45° field of view
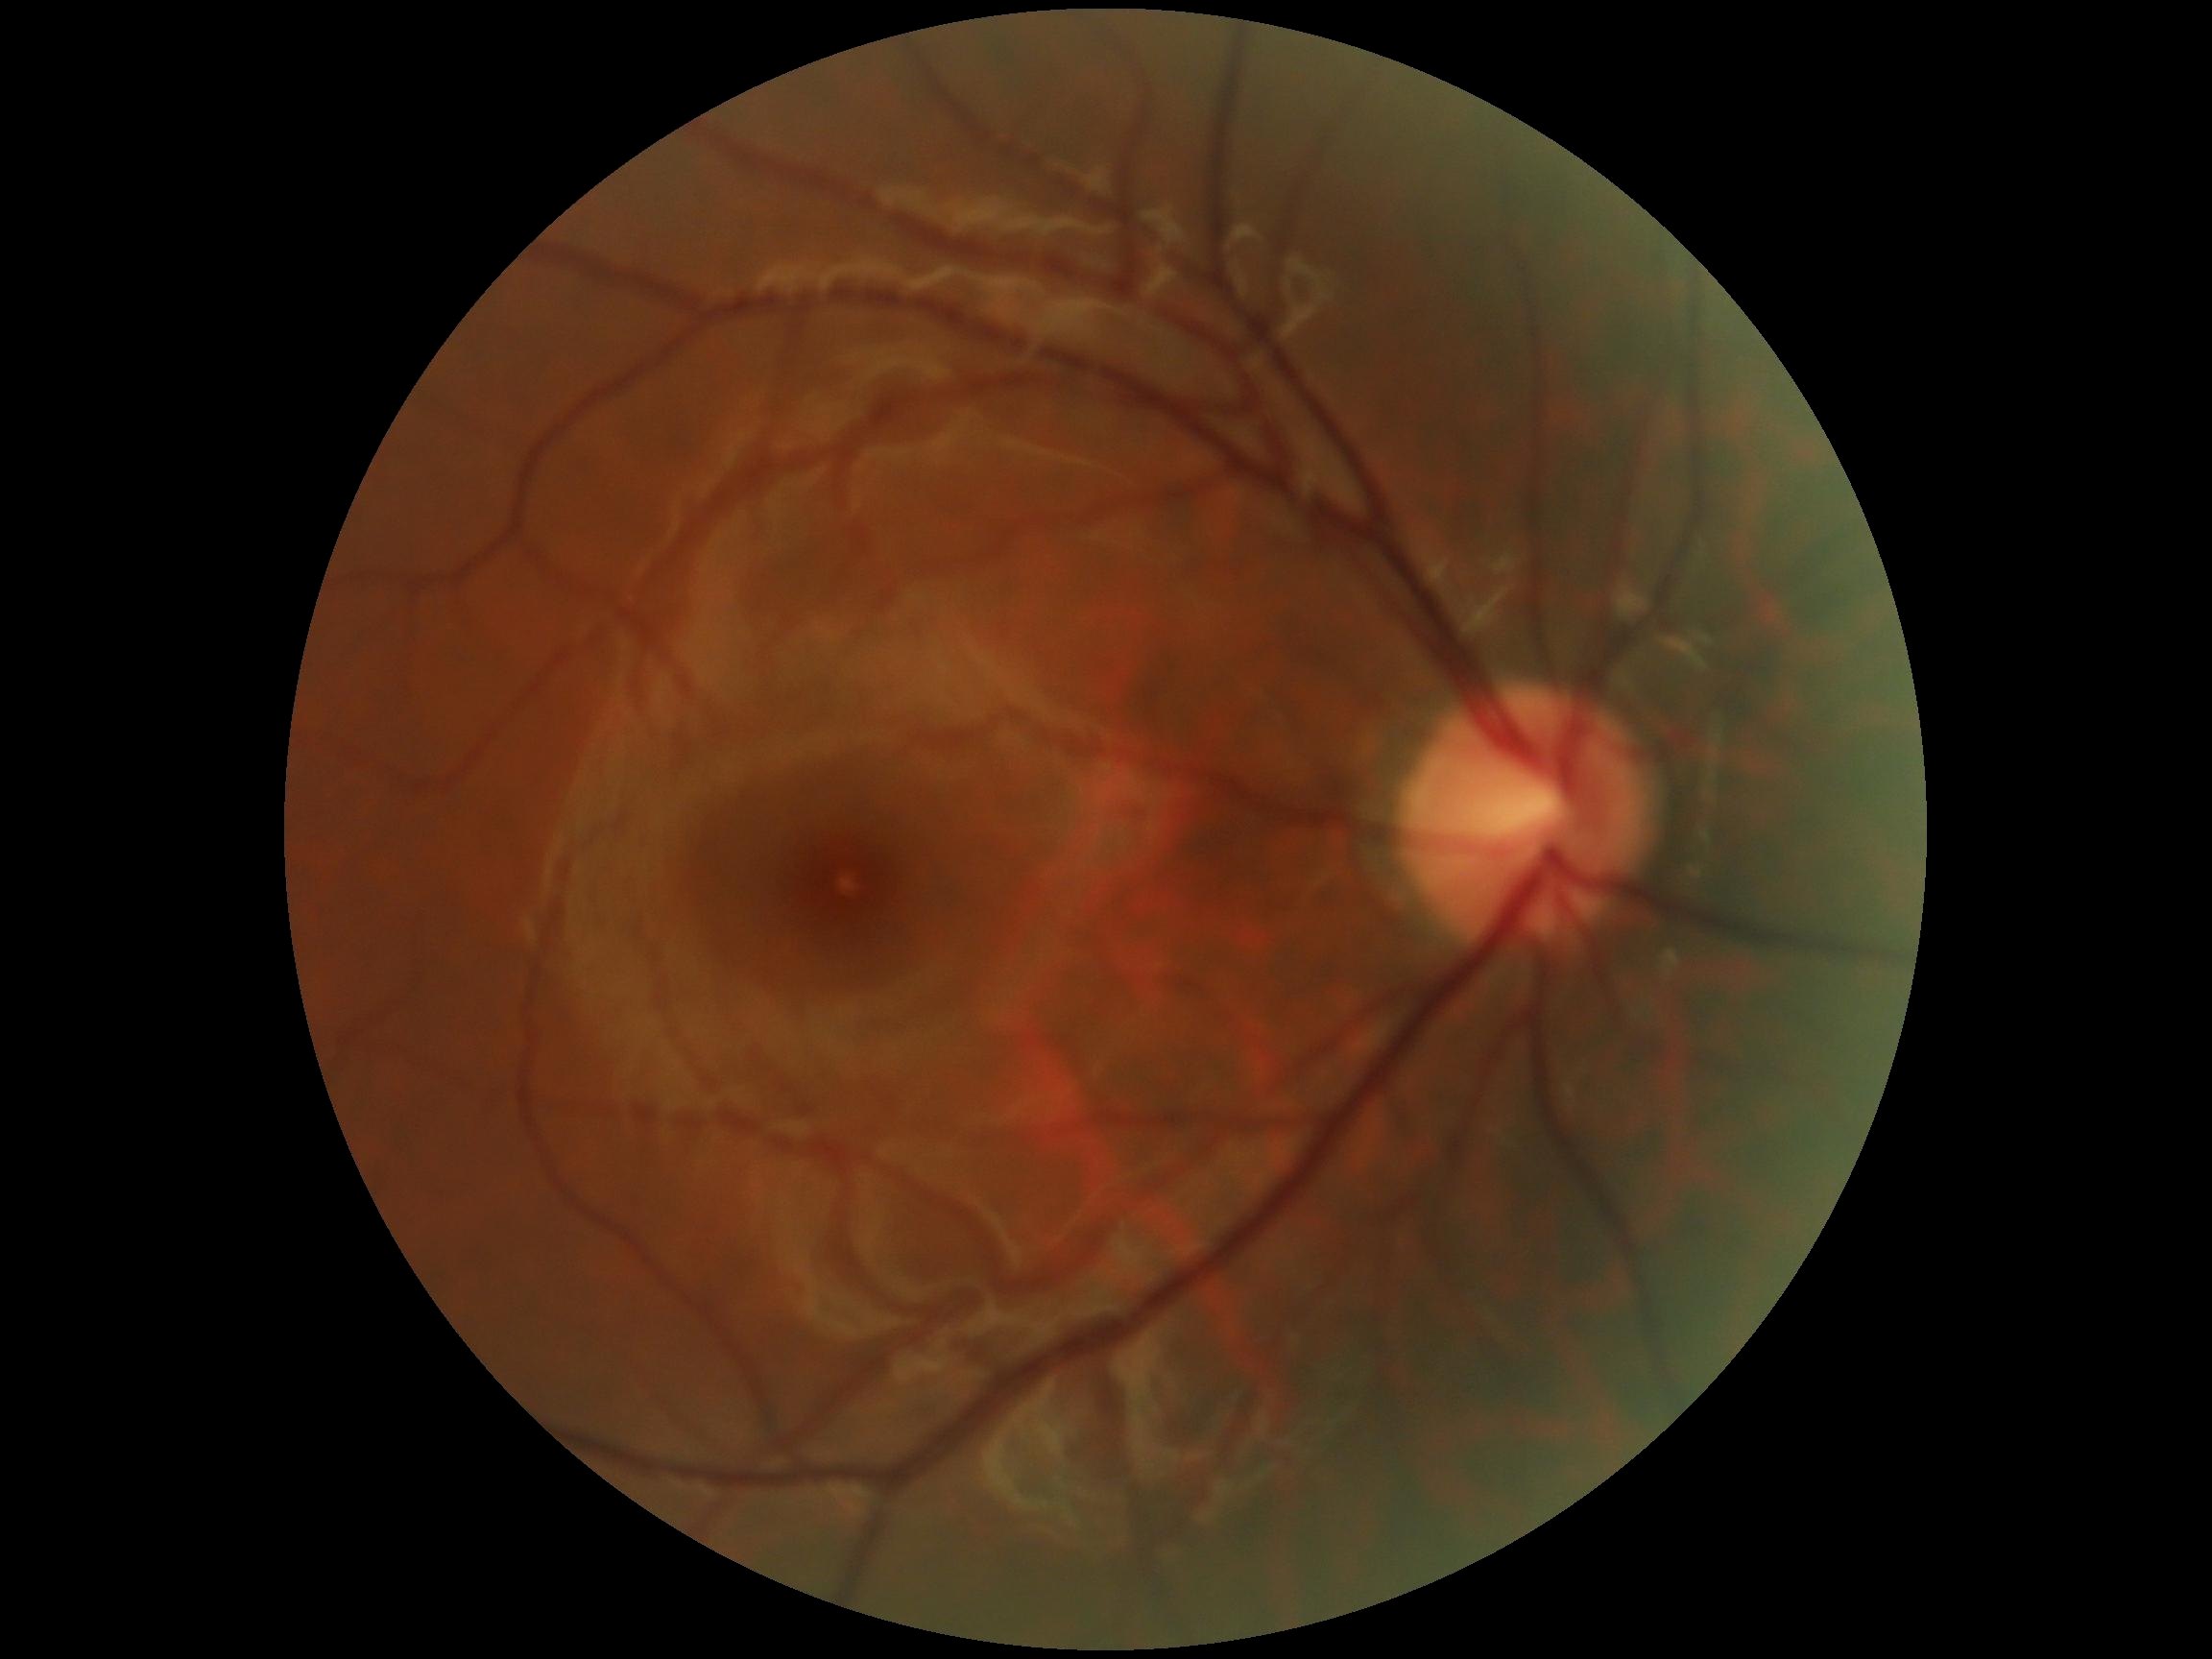 {"dr_grade": "no apparent diabetic retinopathy (grade 0)", "dr_impression": "negative for DR"}